FOV: 50 degrees, captured on a Topcon TRC-50DX fundus camera, mydriatic (tropicamide and phenylephrine), retinal fundus photograph.
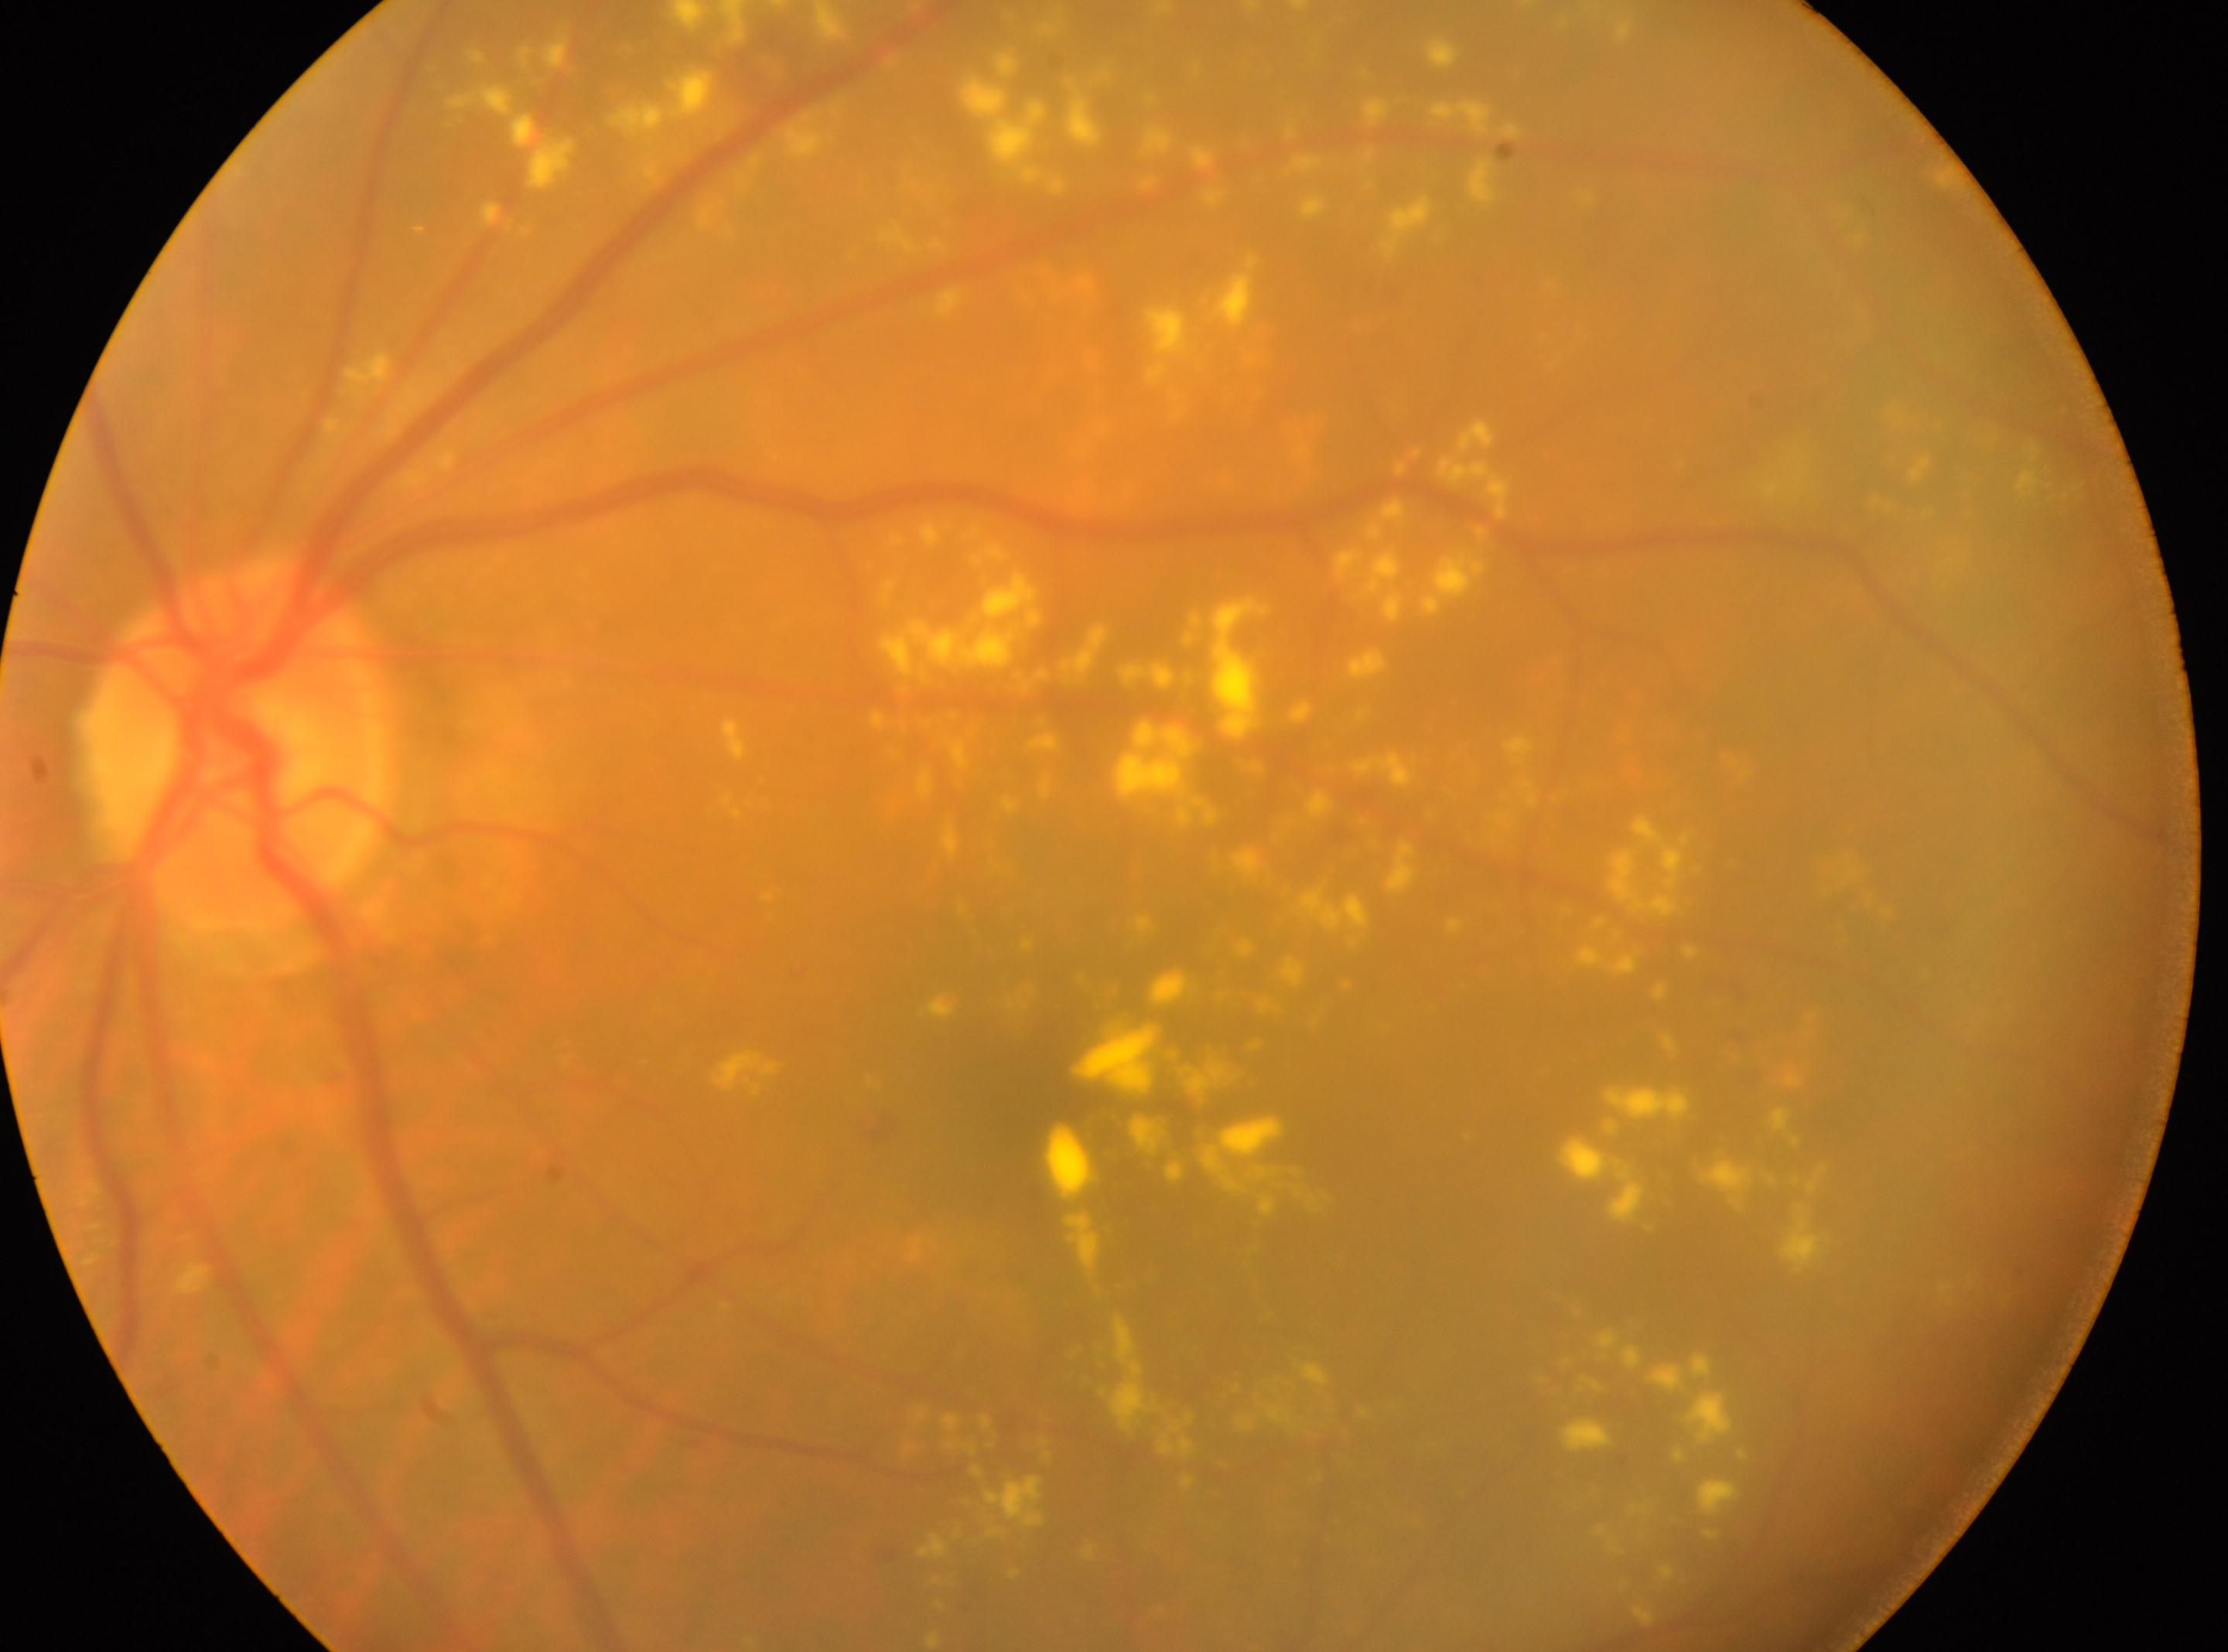
Annotations:
– DR class · non-proliferative diabetic retinopathy
– macula center · 1044px, 1101px
– optic nerve head · 236px, 742px
– DR severity · moderate NPDR (grade 2) — more than just microaneurysms but less than severe NPDR
– laterality · left eye